1240x1240. Pediatric retinal photograph (wide-field).
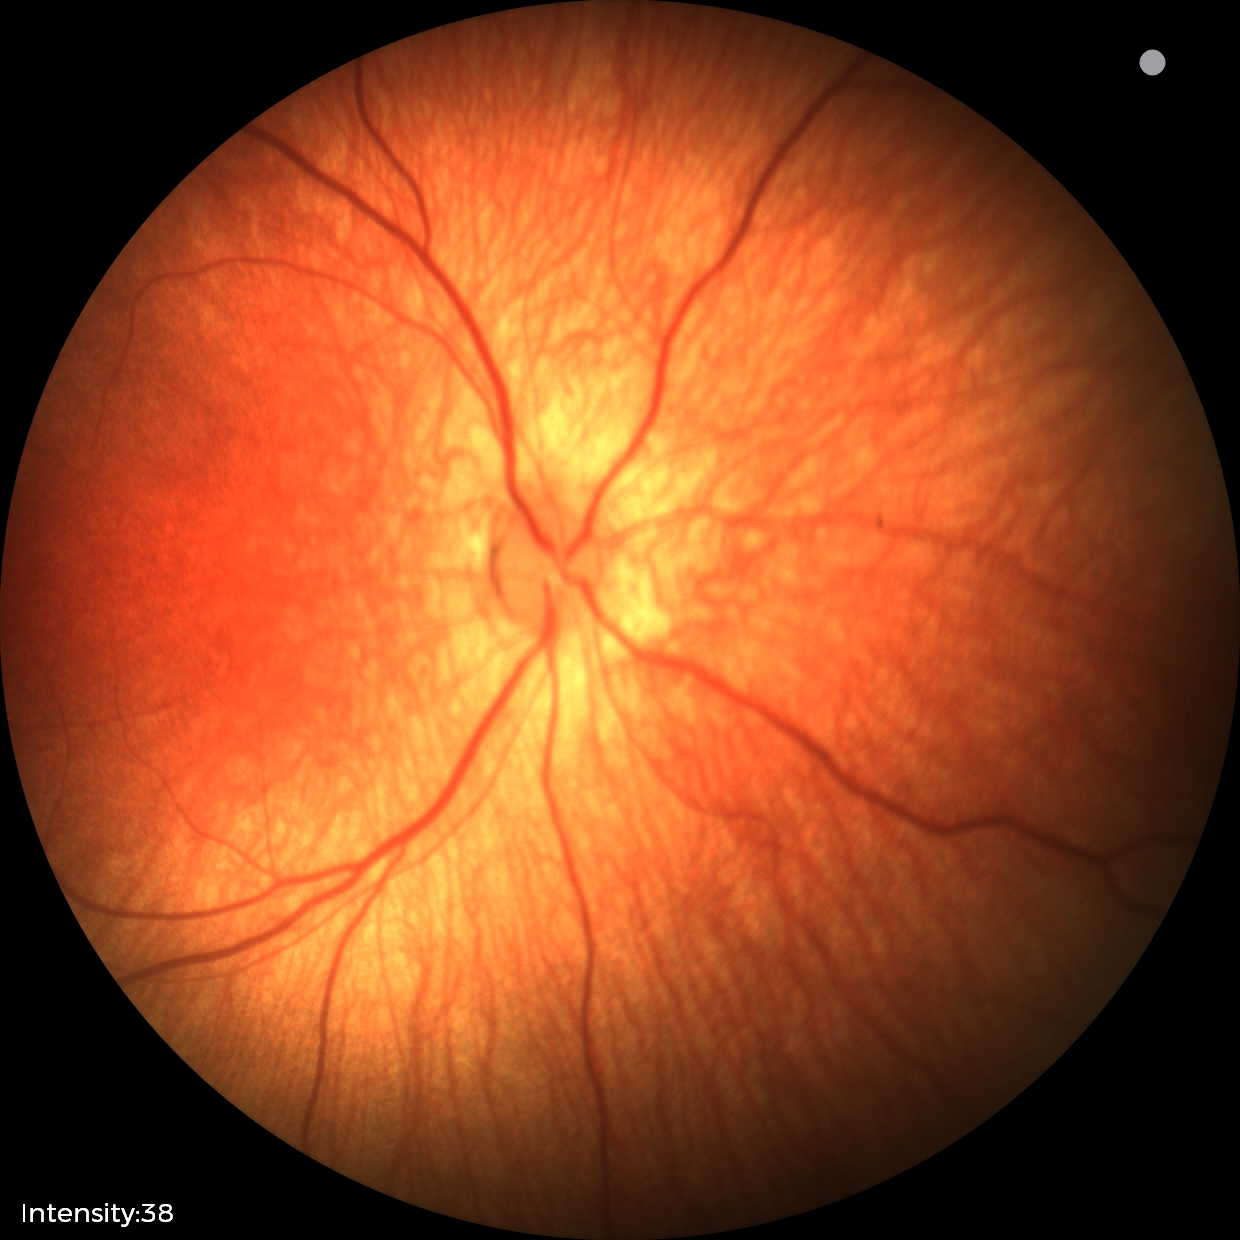 Normal screening examination.